Fundus photo.
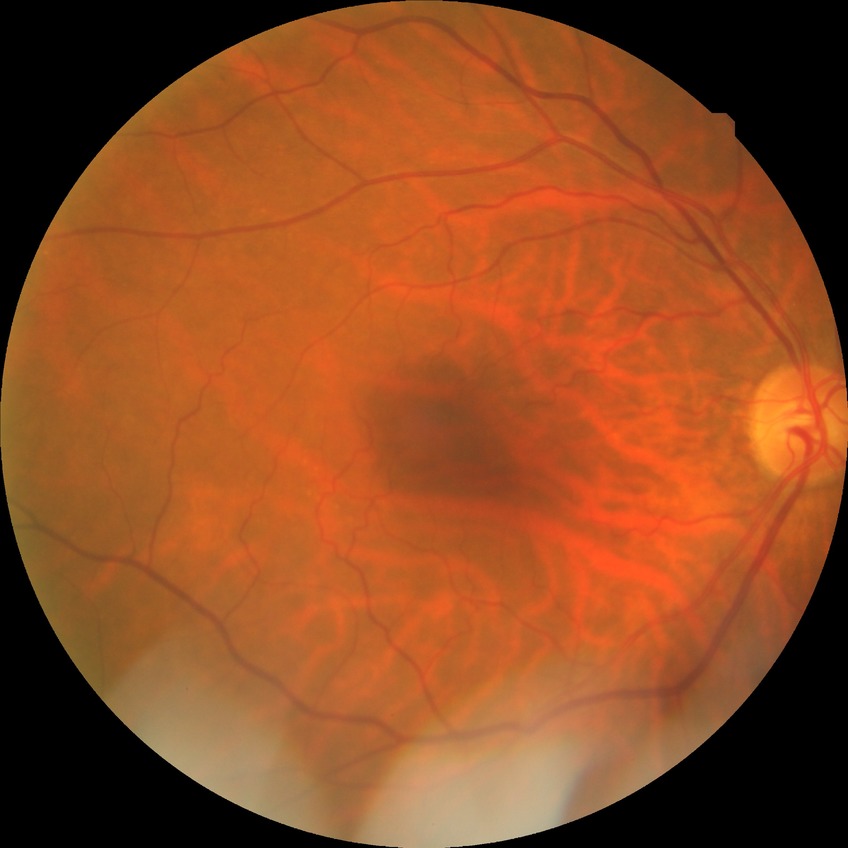

diabetic retinopathy (DR): no diabetic retinopathy (NDR)